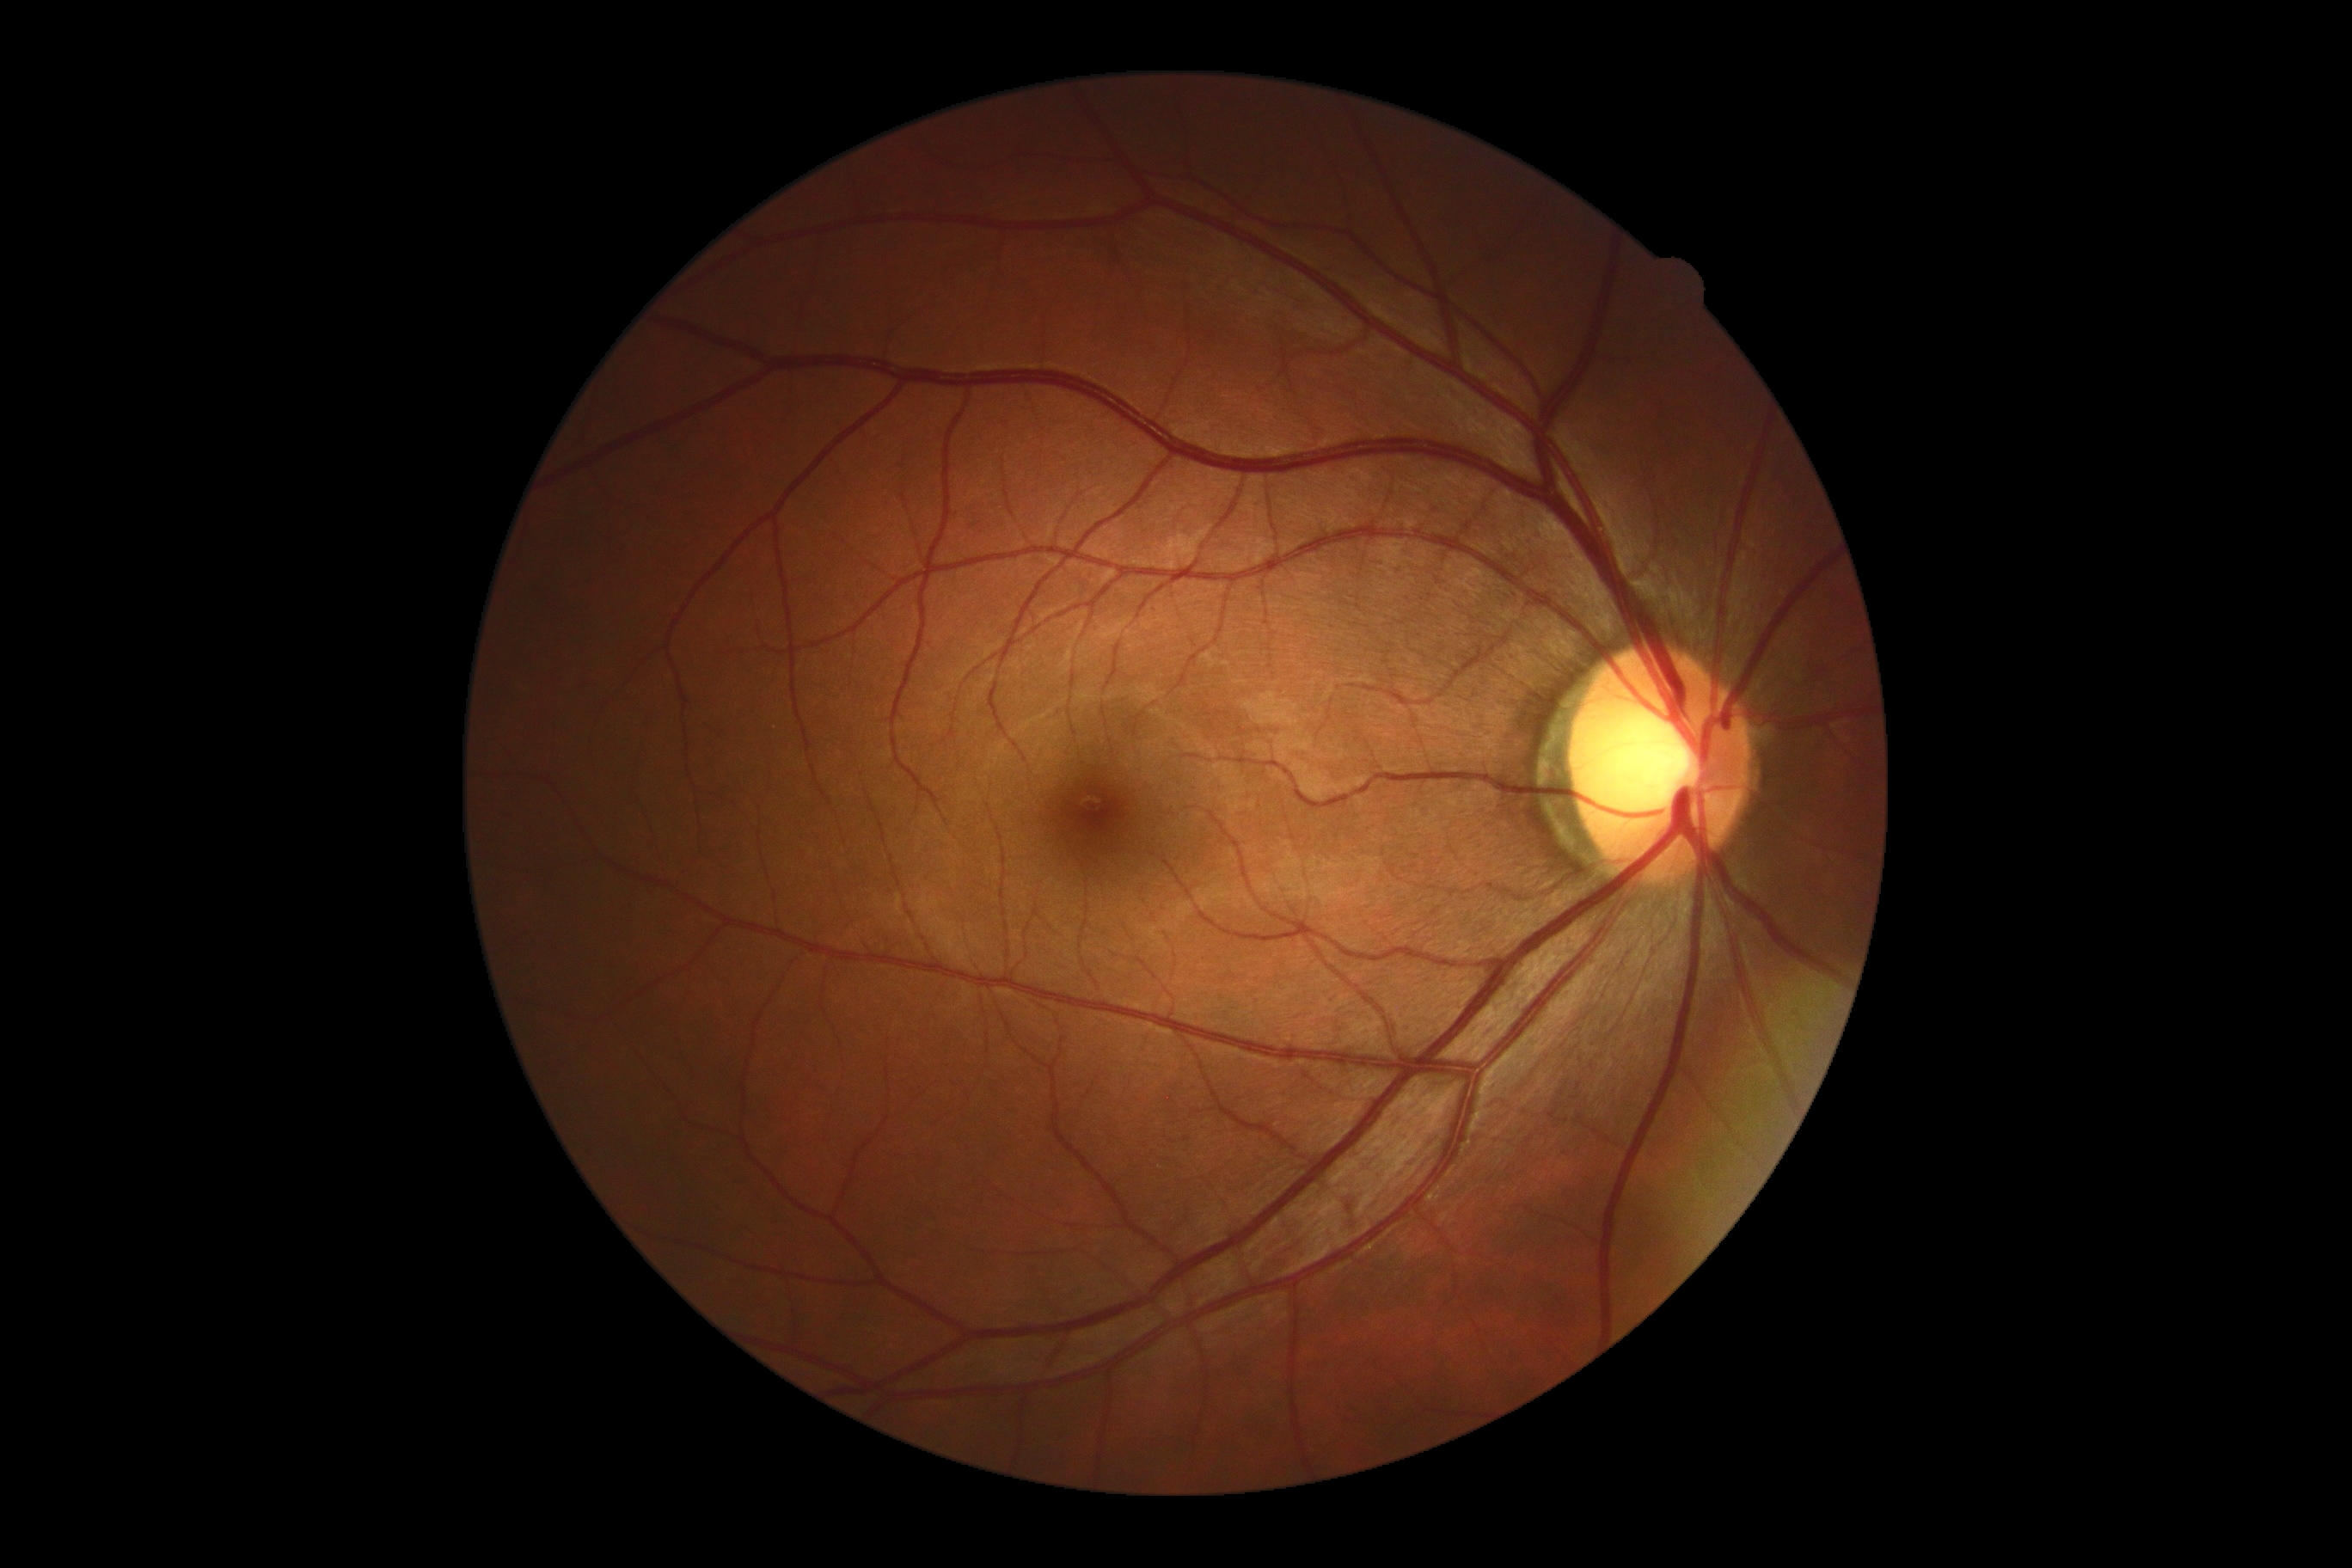 DR grade: 0/4 — no visible signs of diabetic retinopathy.